Captured with the Clarity RetCam 3 (130° field of view) · wide-field contact fundus photograph of an infant · 640x480: 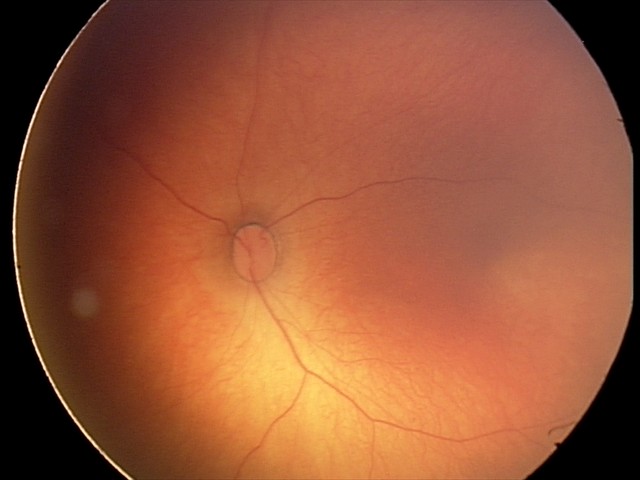
Screening diagnosis: physiological finding.